Infant wide-field retinal image; Clarity RetCam 3, 130° FOV:
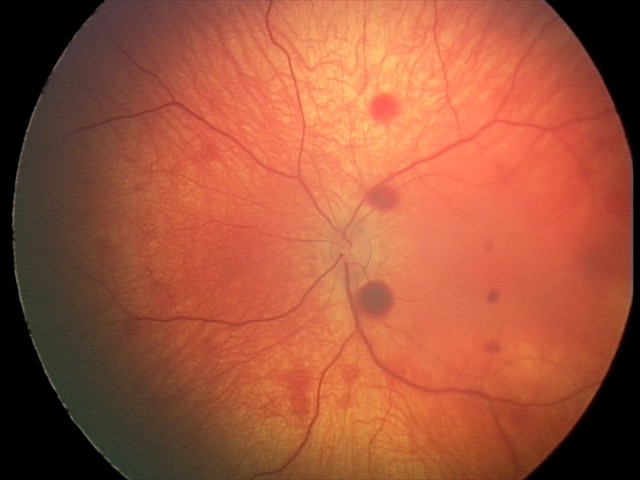

Screening diagnosis: retinal hemorrhages.